60° FOV. Handheld portable fundus camera image: 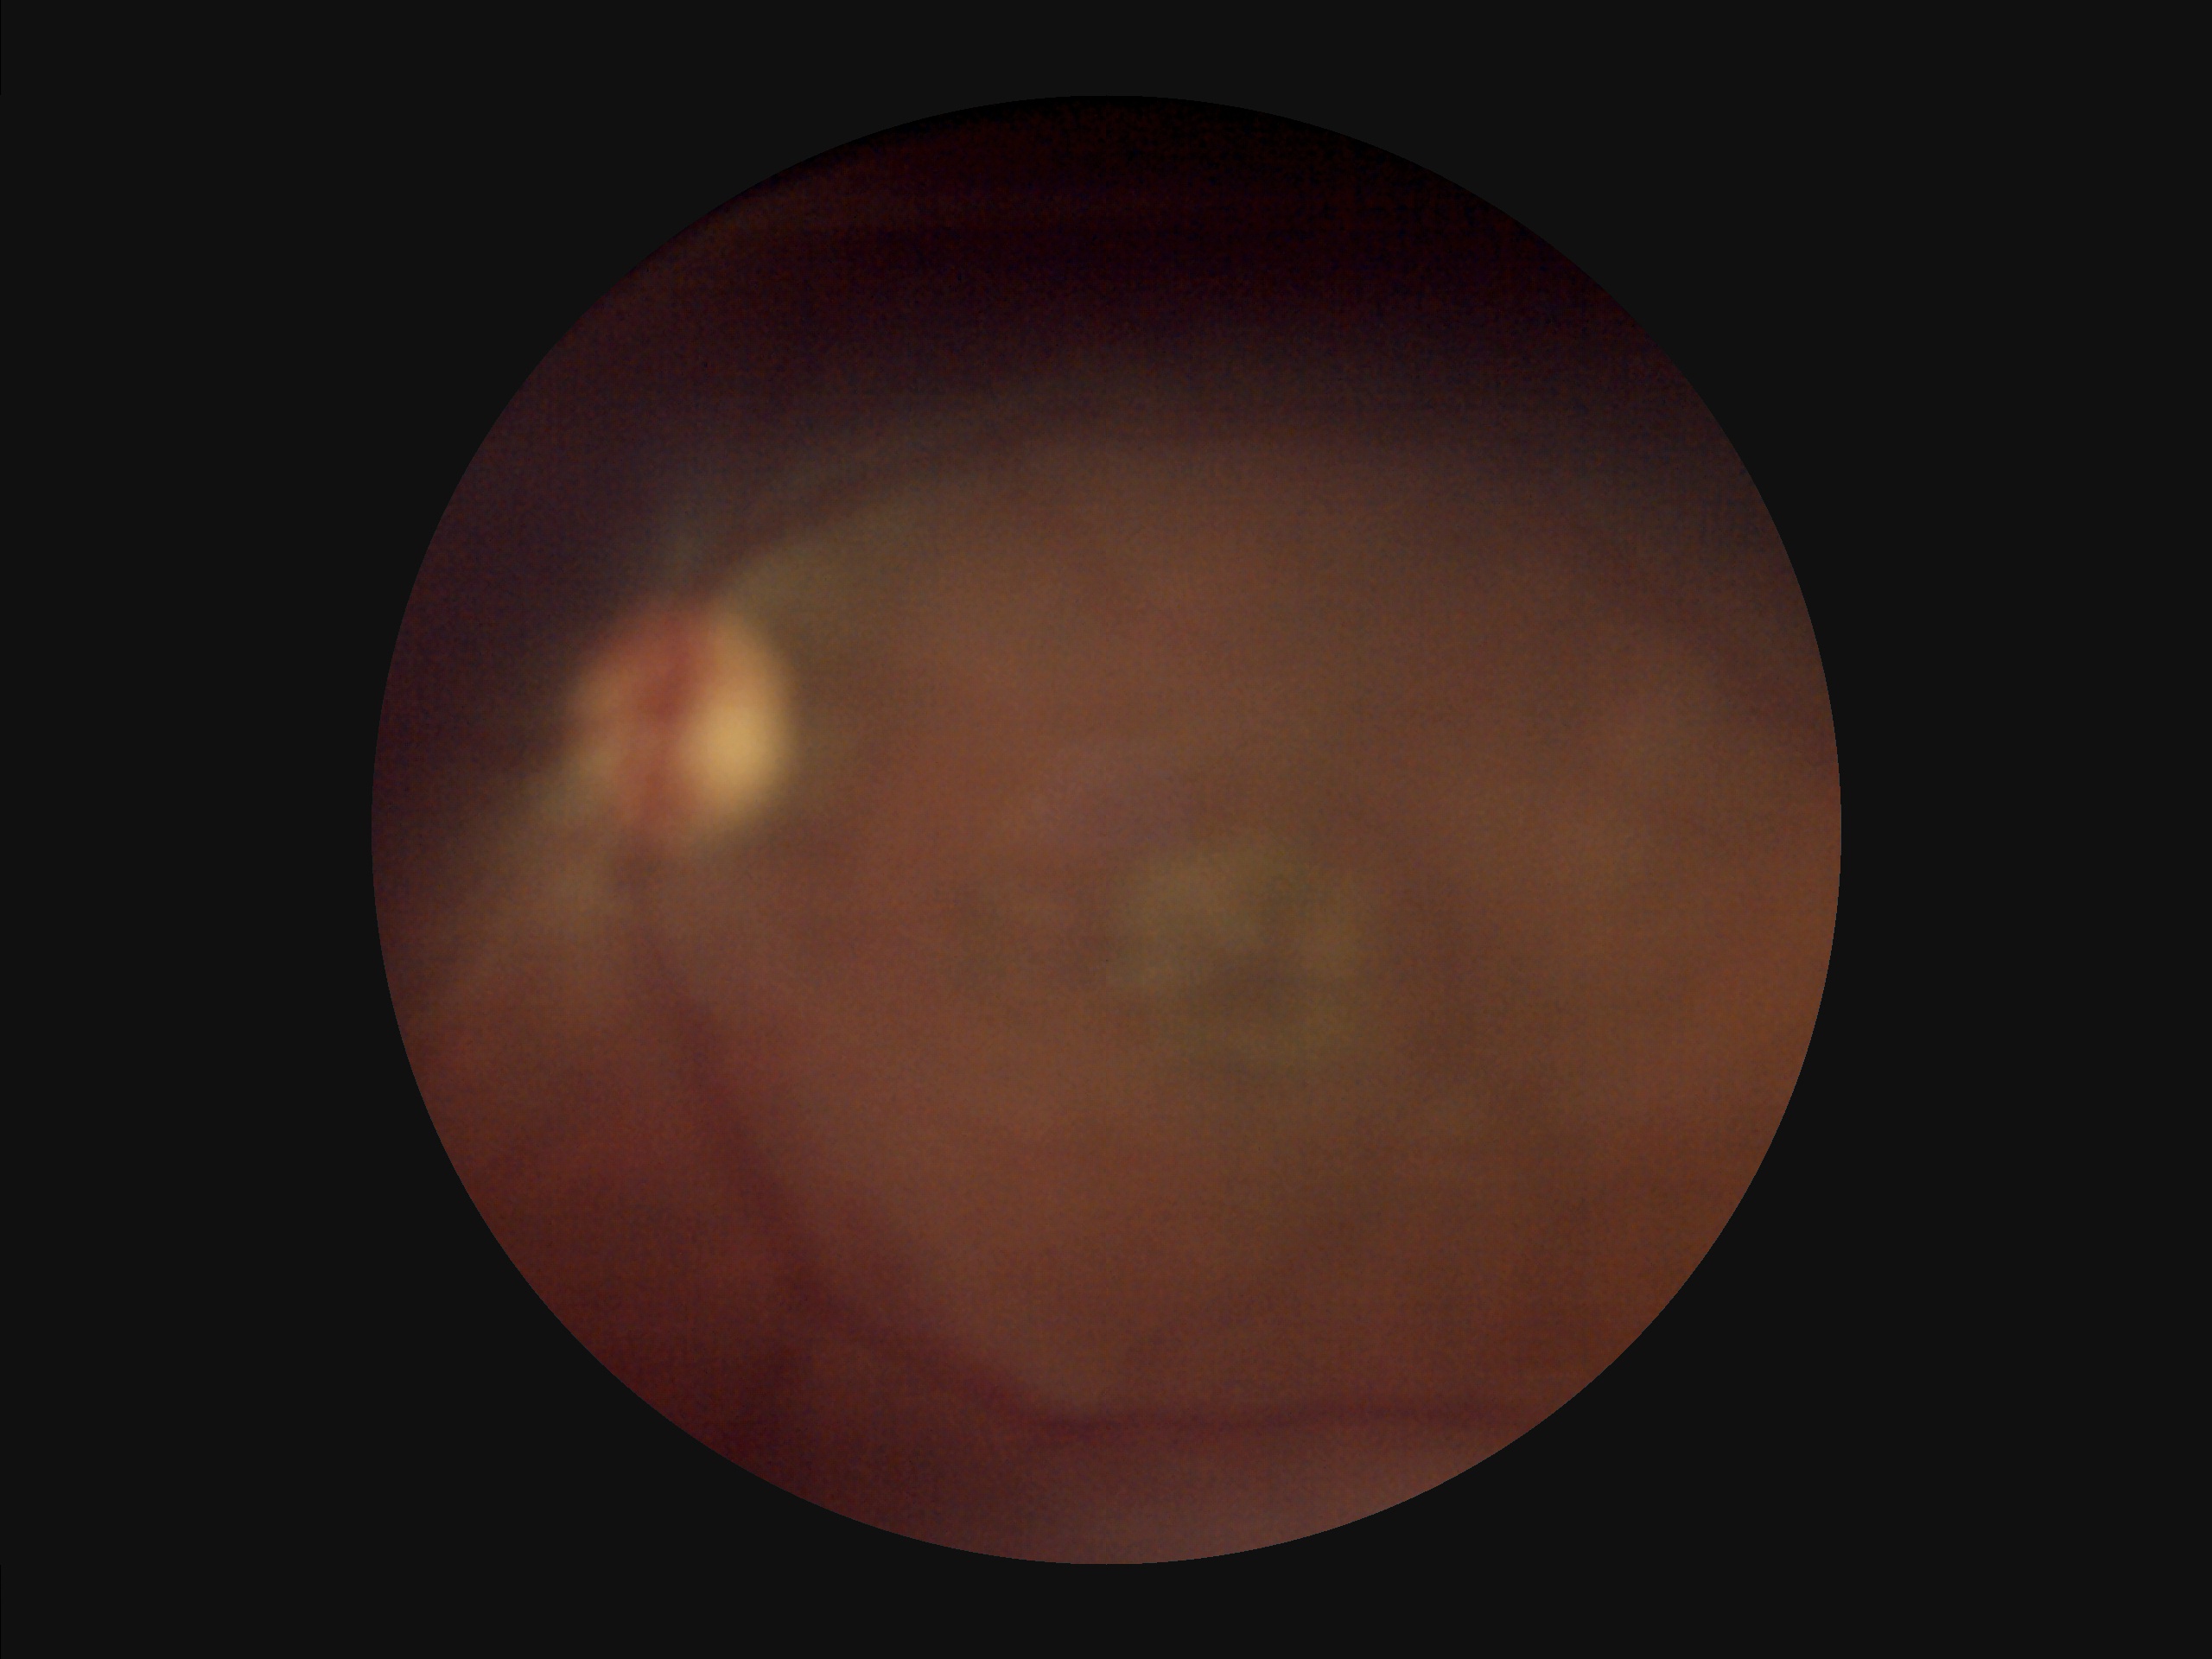 Poor illumination with uneven exposure. Contrast is low. Noticeable blur in the optic disc, vessels, or background. Image quality is suboptimal.